Modified Davis grading.
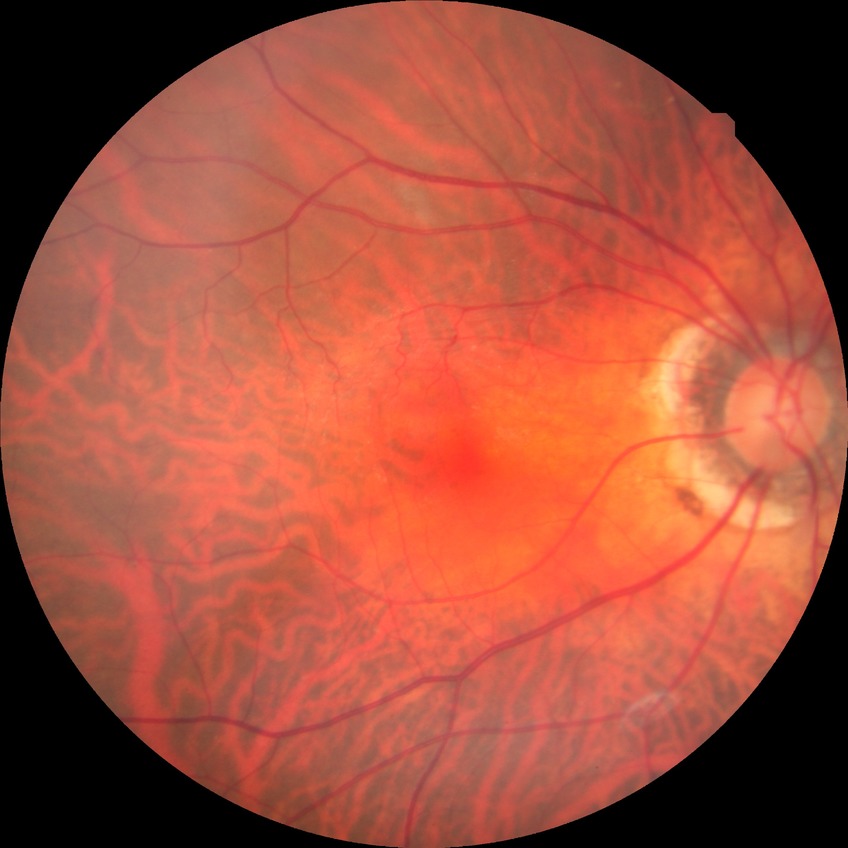 Diabetic retinopathy (DR): no diabetic retinopathy (NDR).